Posterior pole field covering the optic disc and macula: 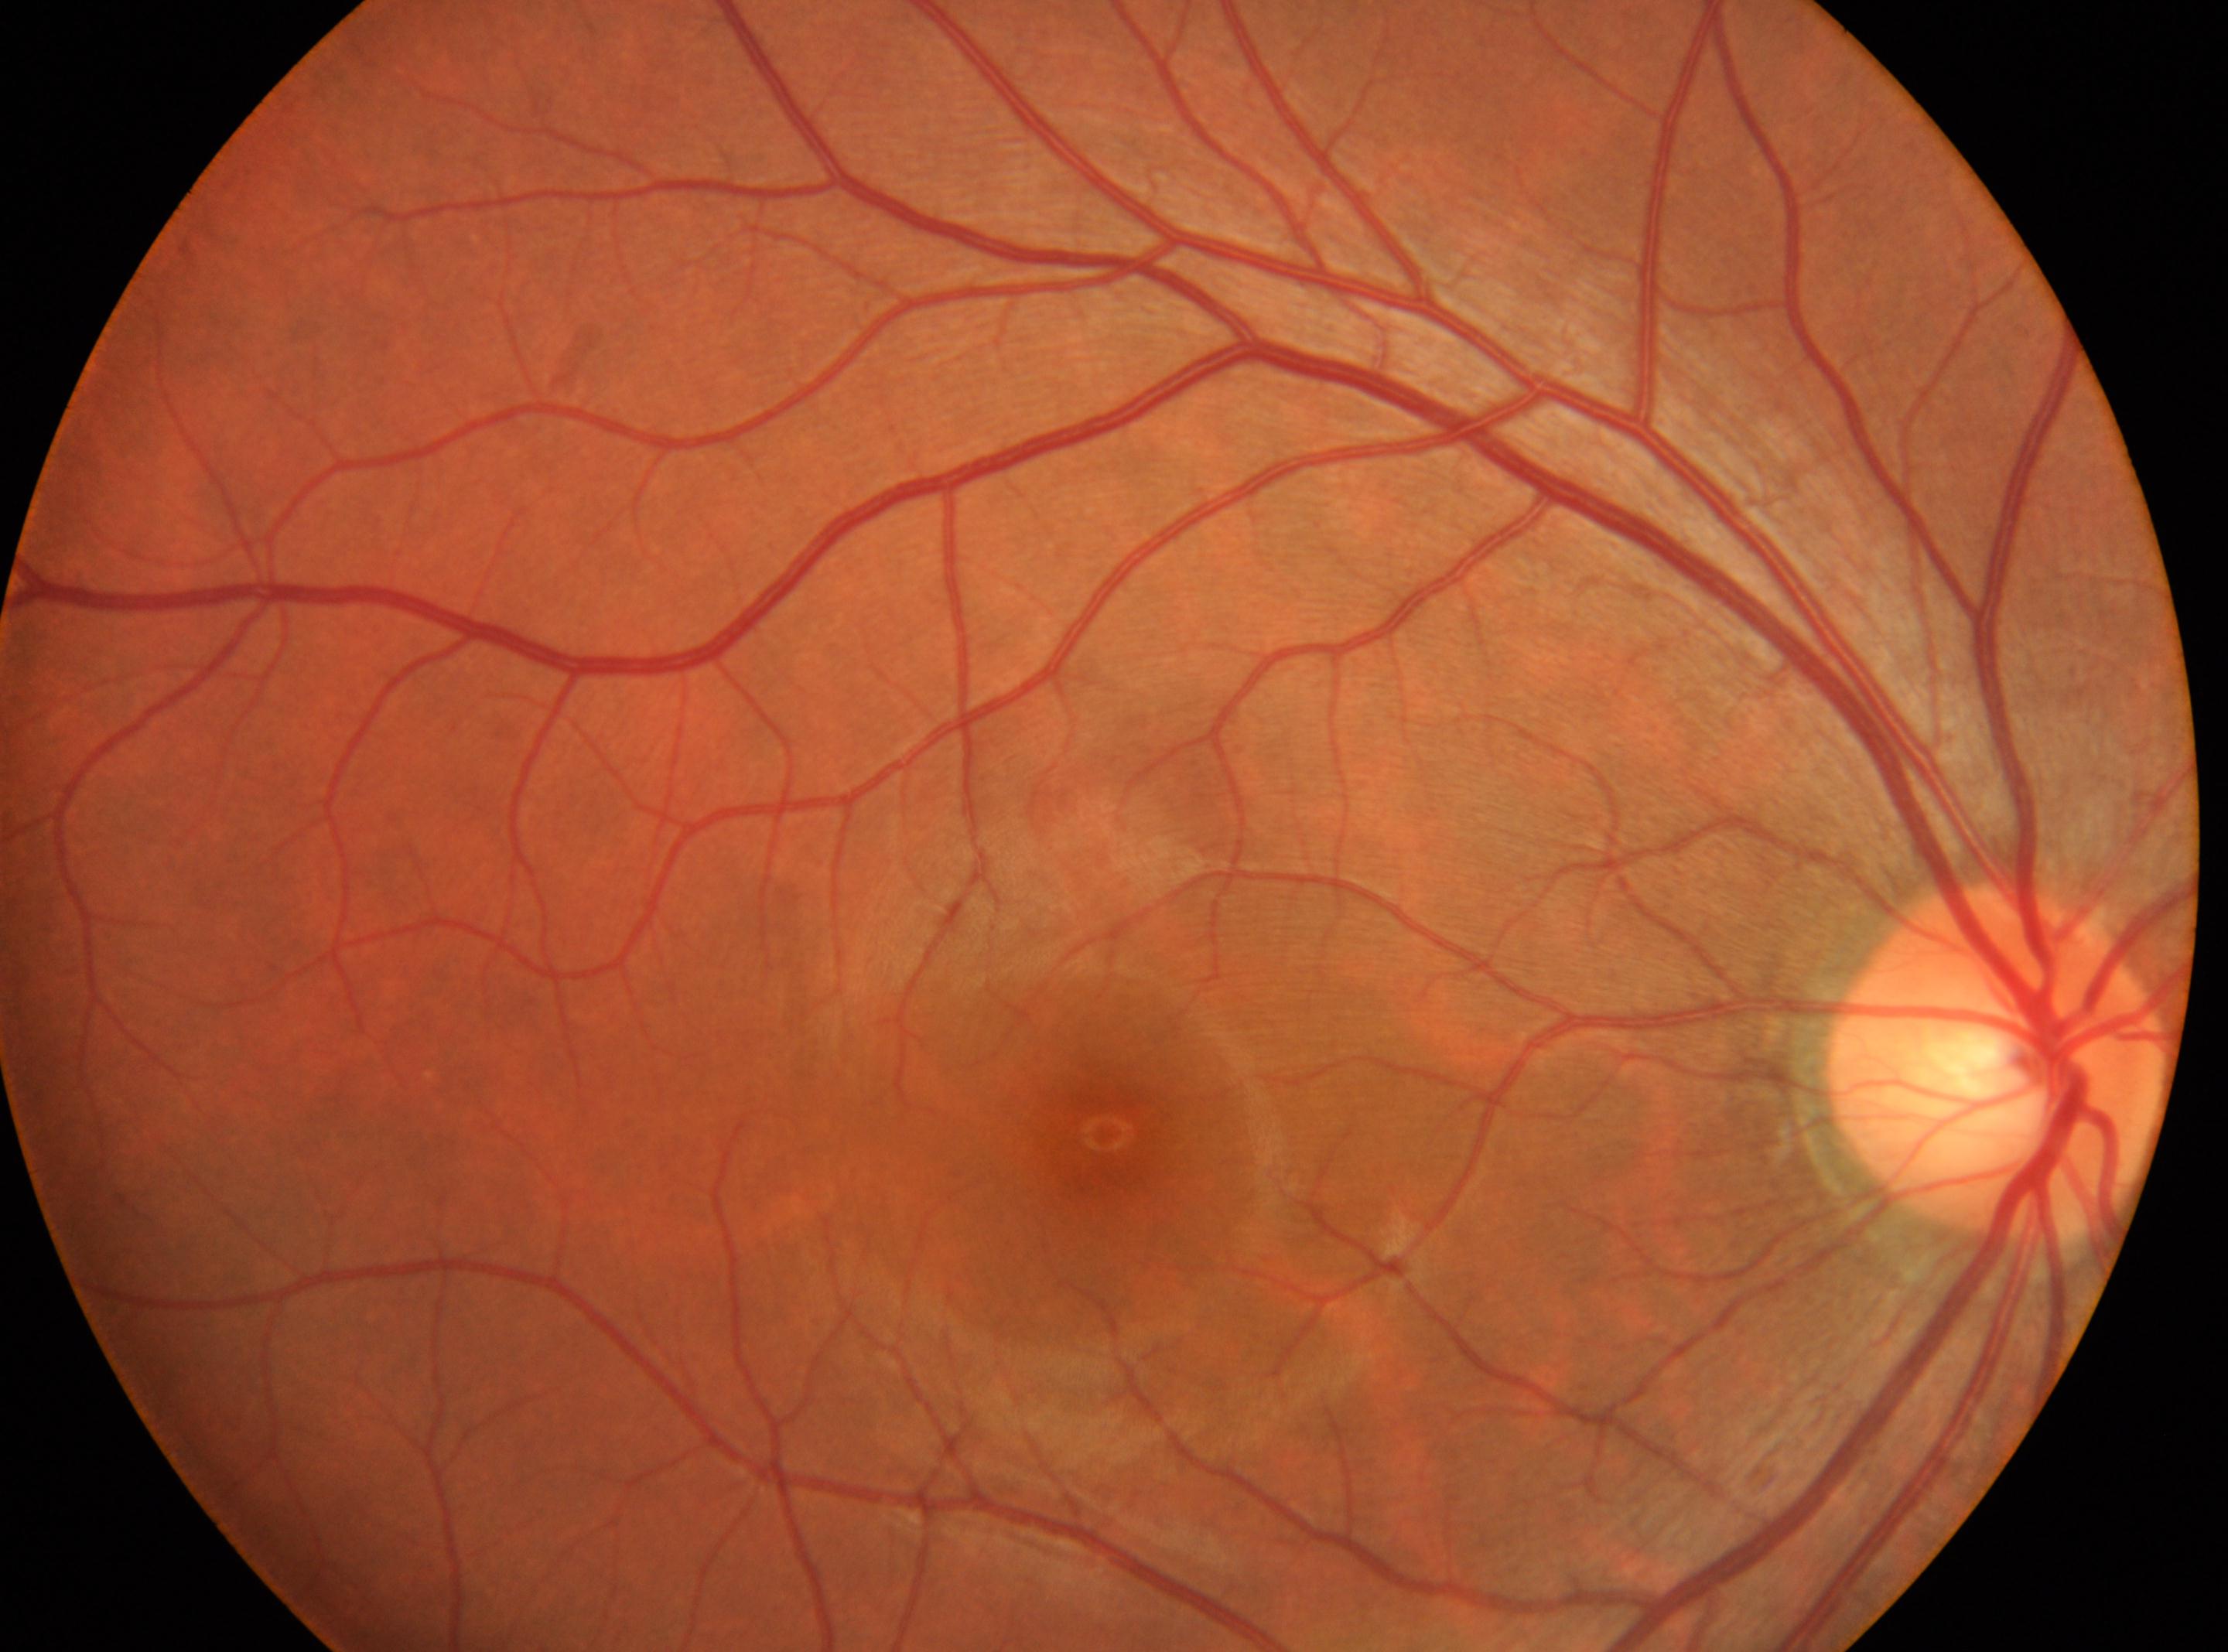

Fovea located at x=1105, y=1134.
Eye: the right eye.
The ONH is at x=1999, y=1060.
DR stage is no apparent diabetic retinopathy (grade 0).